Retinal fundus photograph:
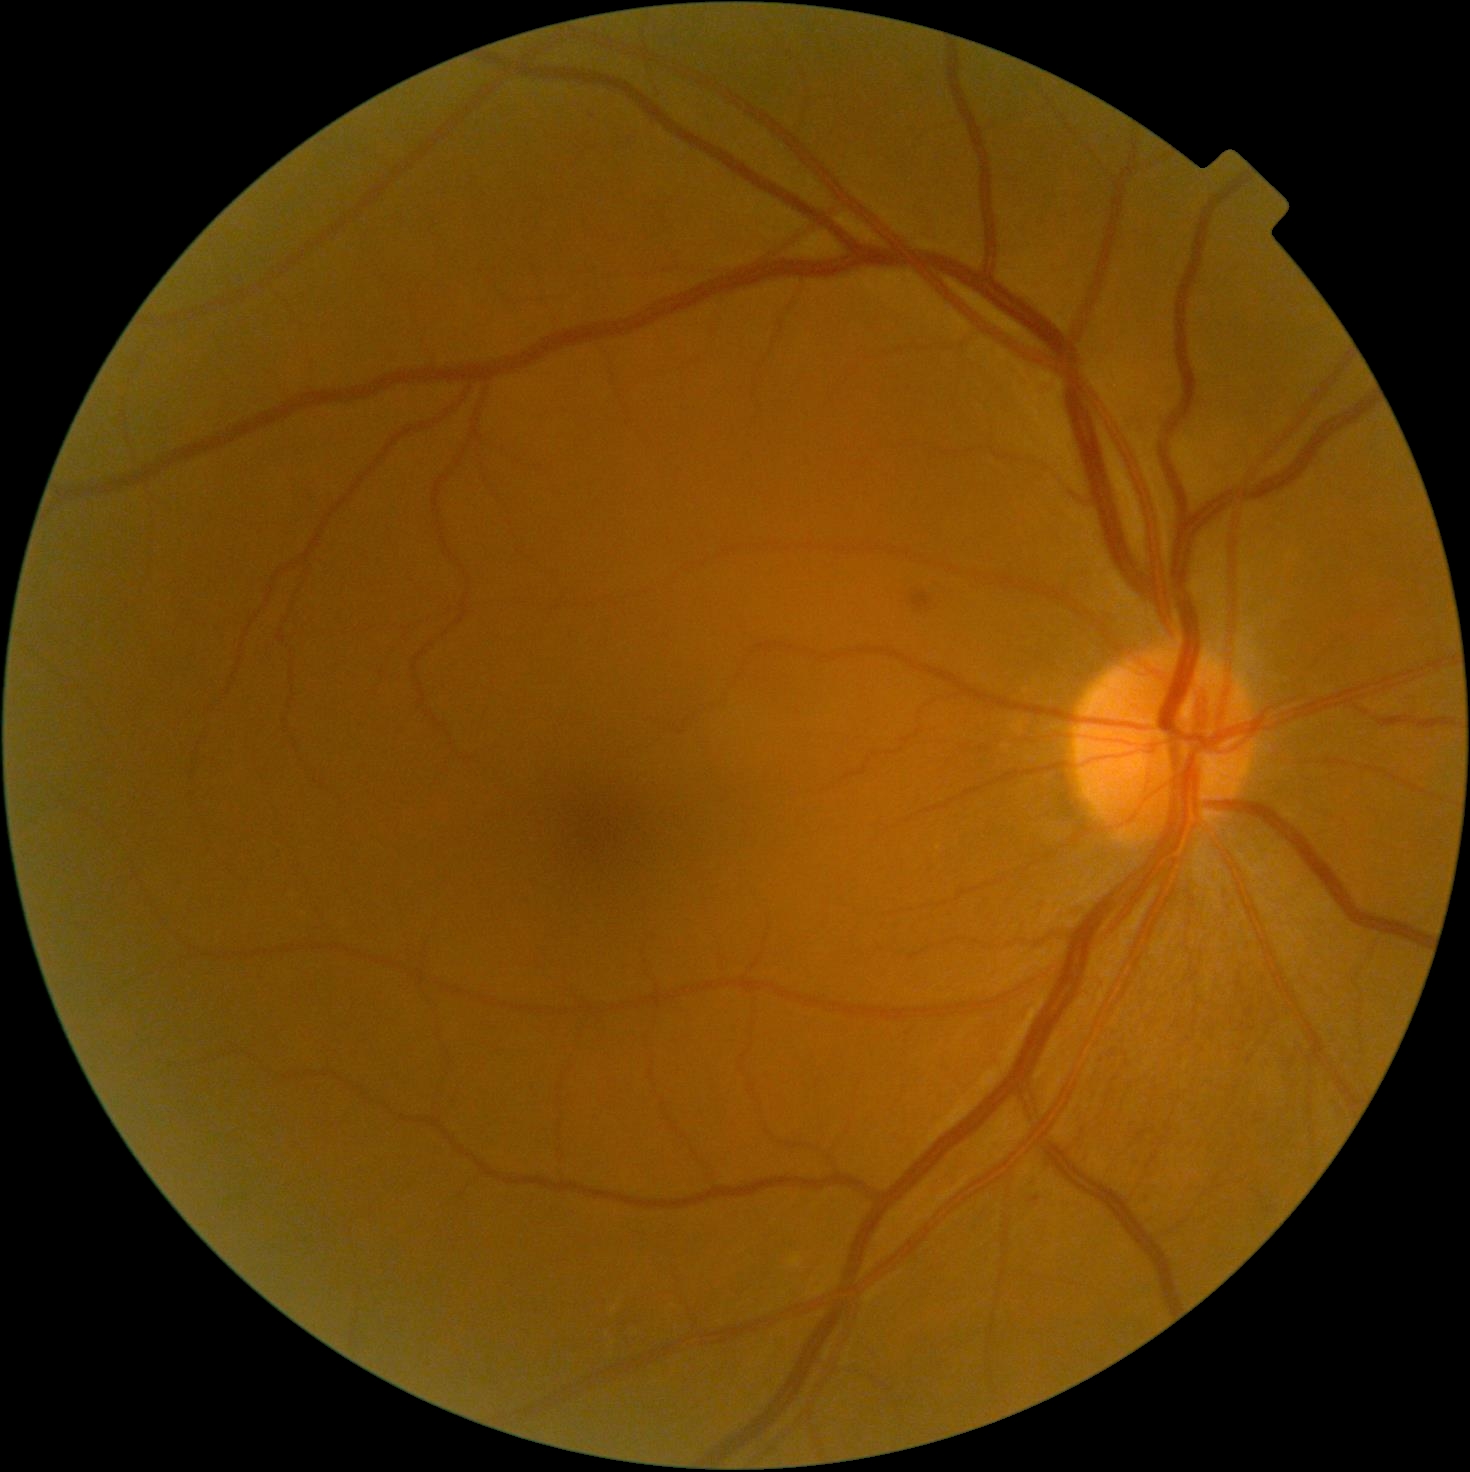 The retinopathy is classified as non-proliferative diabetic retinopathy. DR: grade 2.